FOV: 45 degrees.
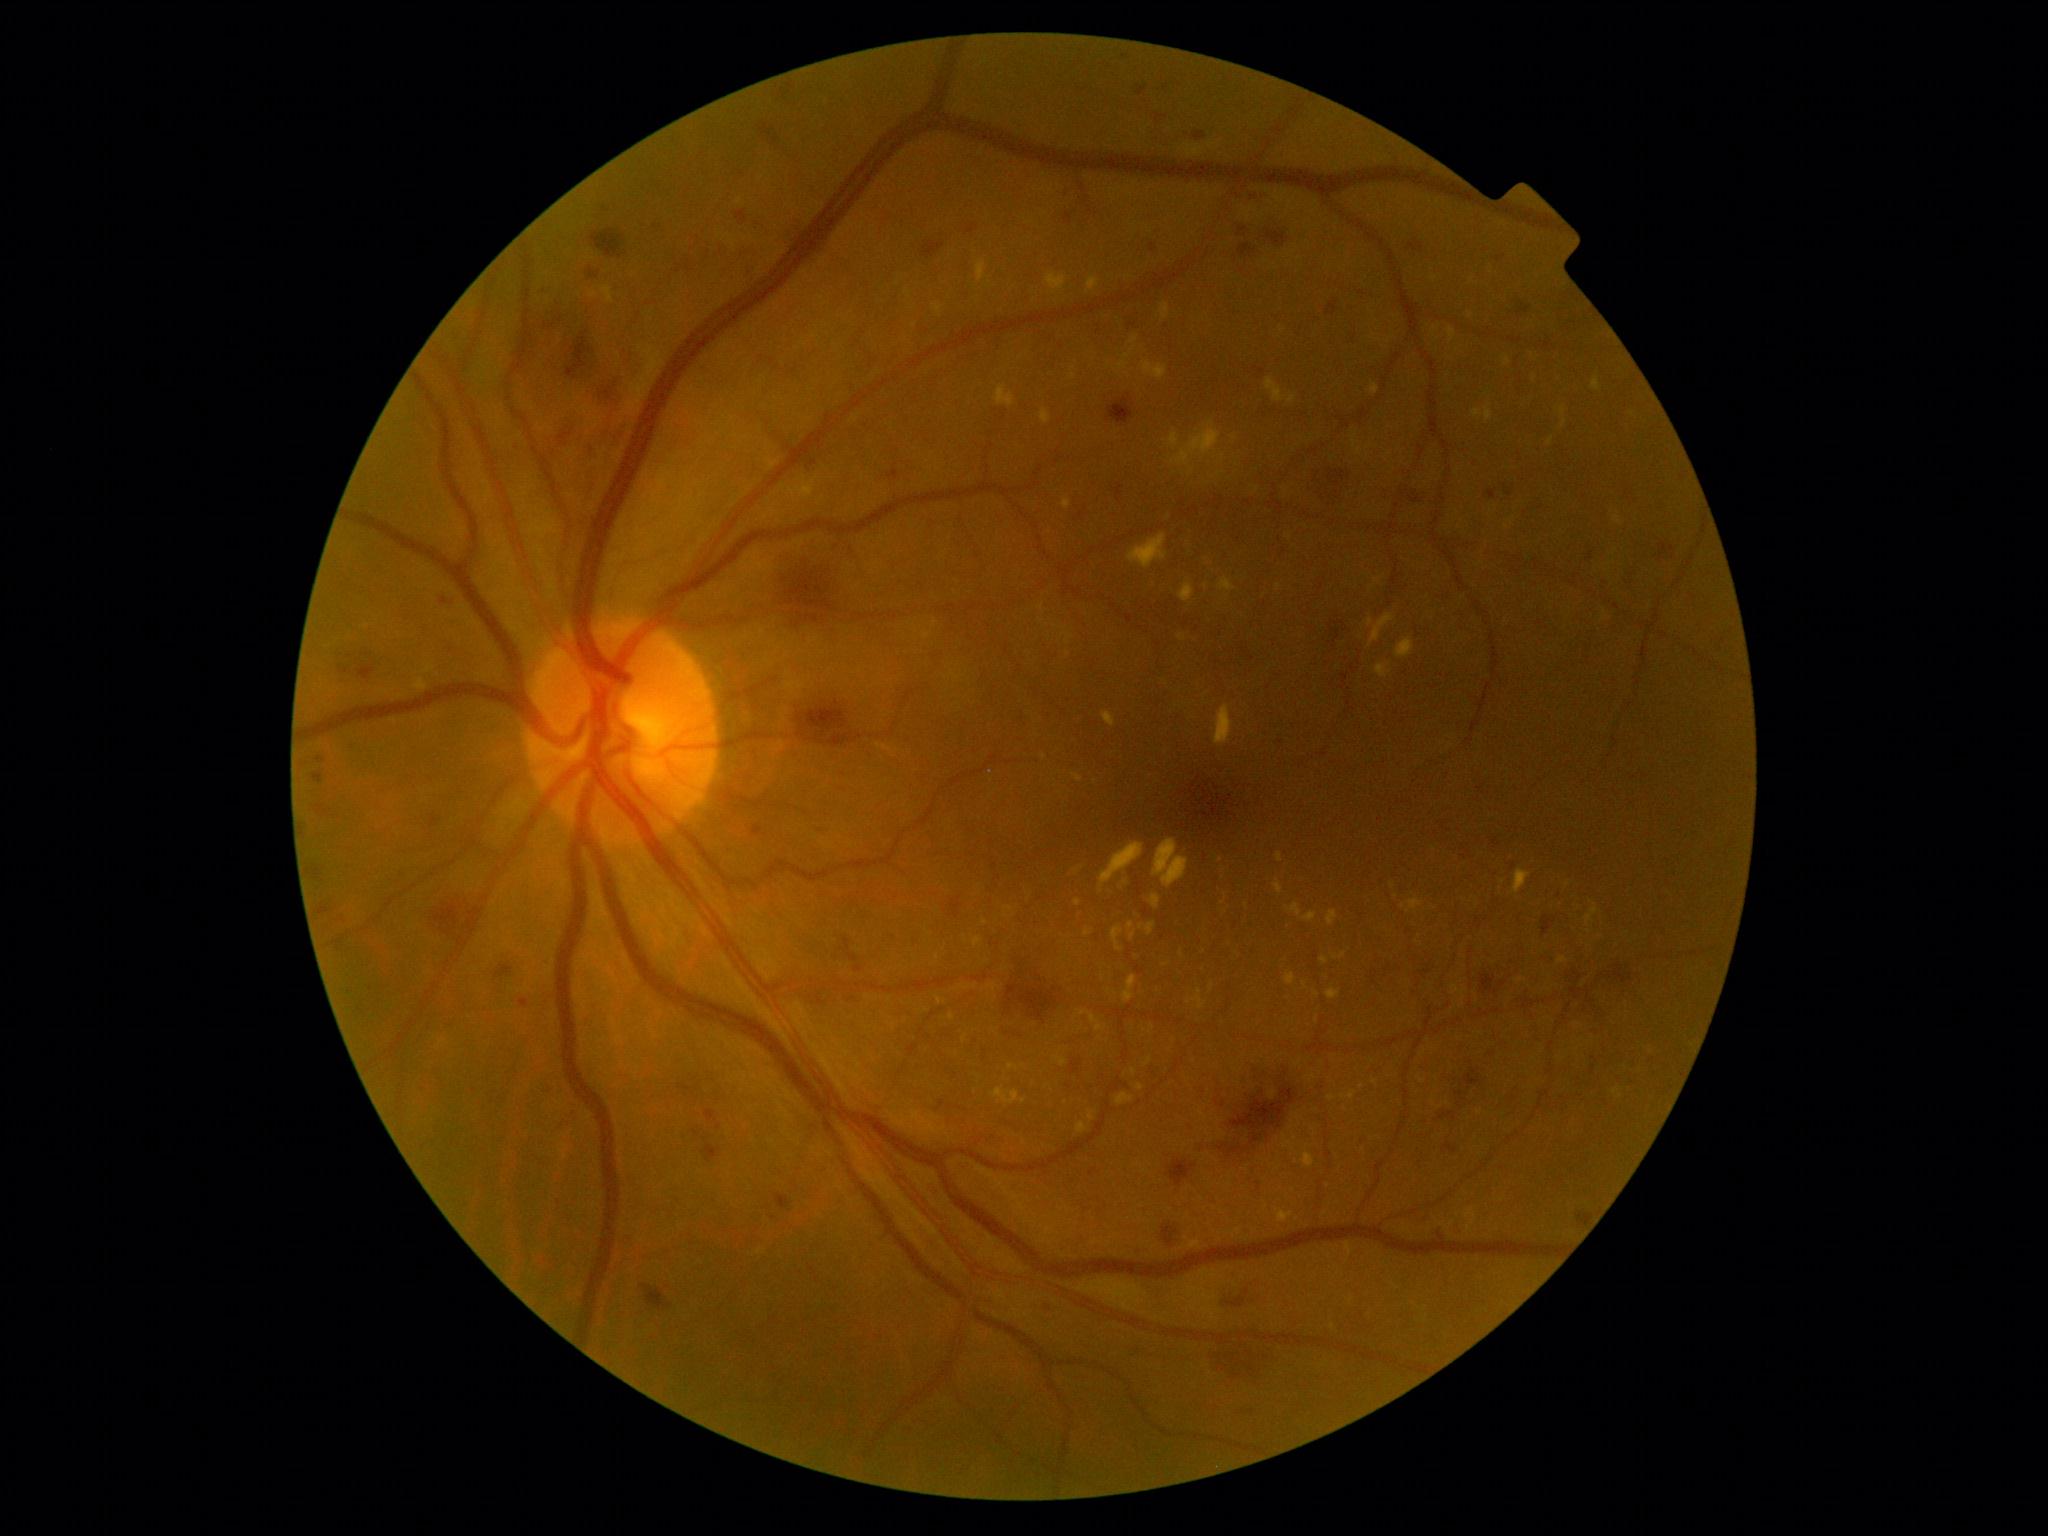 Diabetic retinopathy (DR) is severe NPDR (grade 3) — more than 20 intraretinal hemorrhages in each of 4 quadrants, definite venous beading in 2 or more quadrants, or prominent intraretinal microvascular abnormalities in 1 or more quadrants, with no signs of proliferative retinopathy.